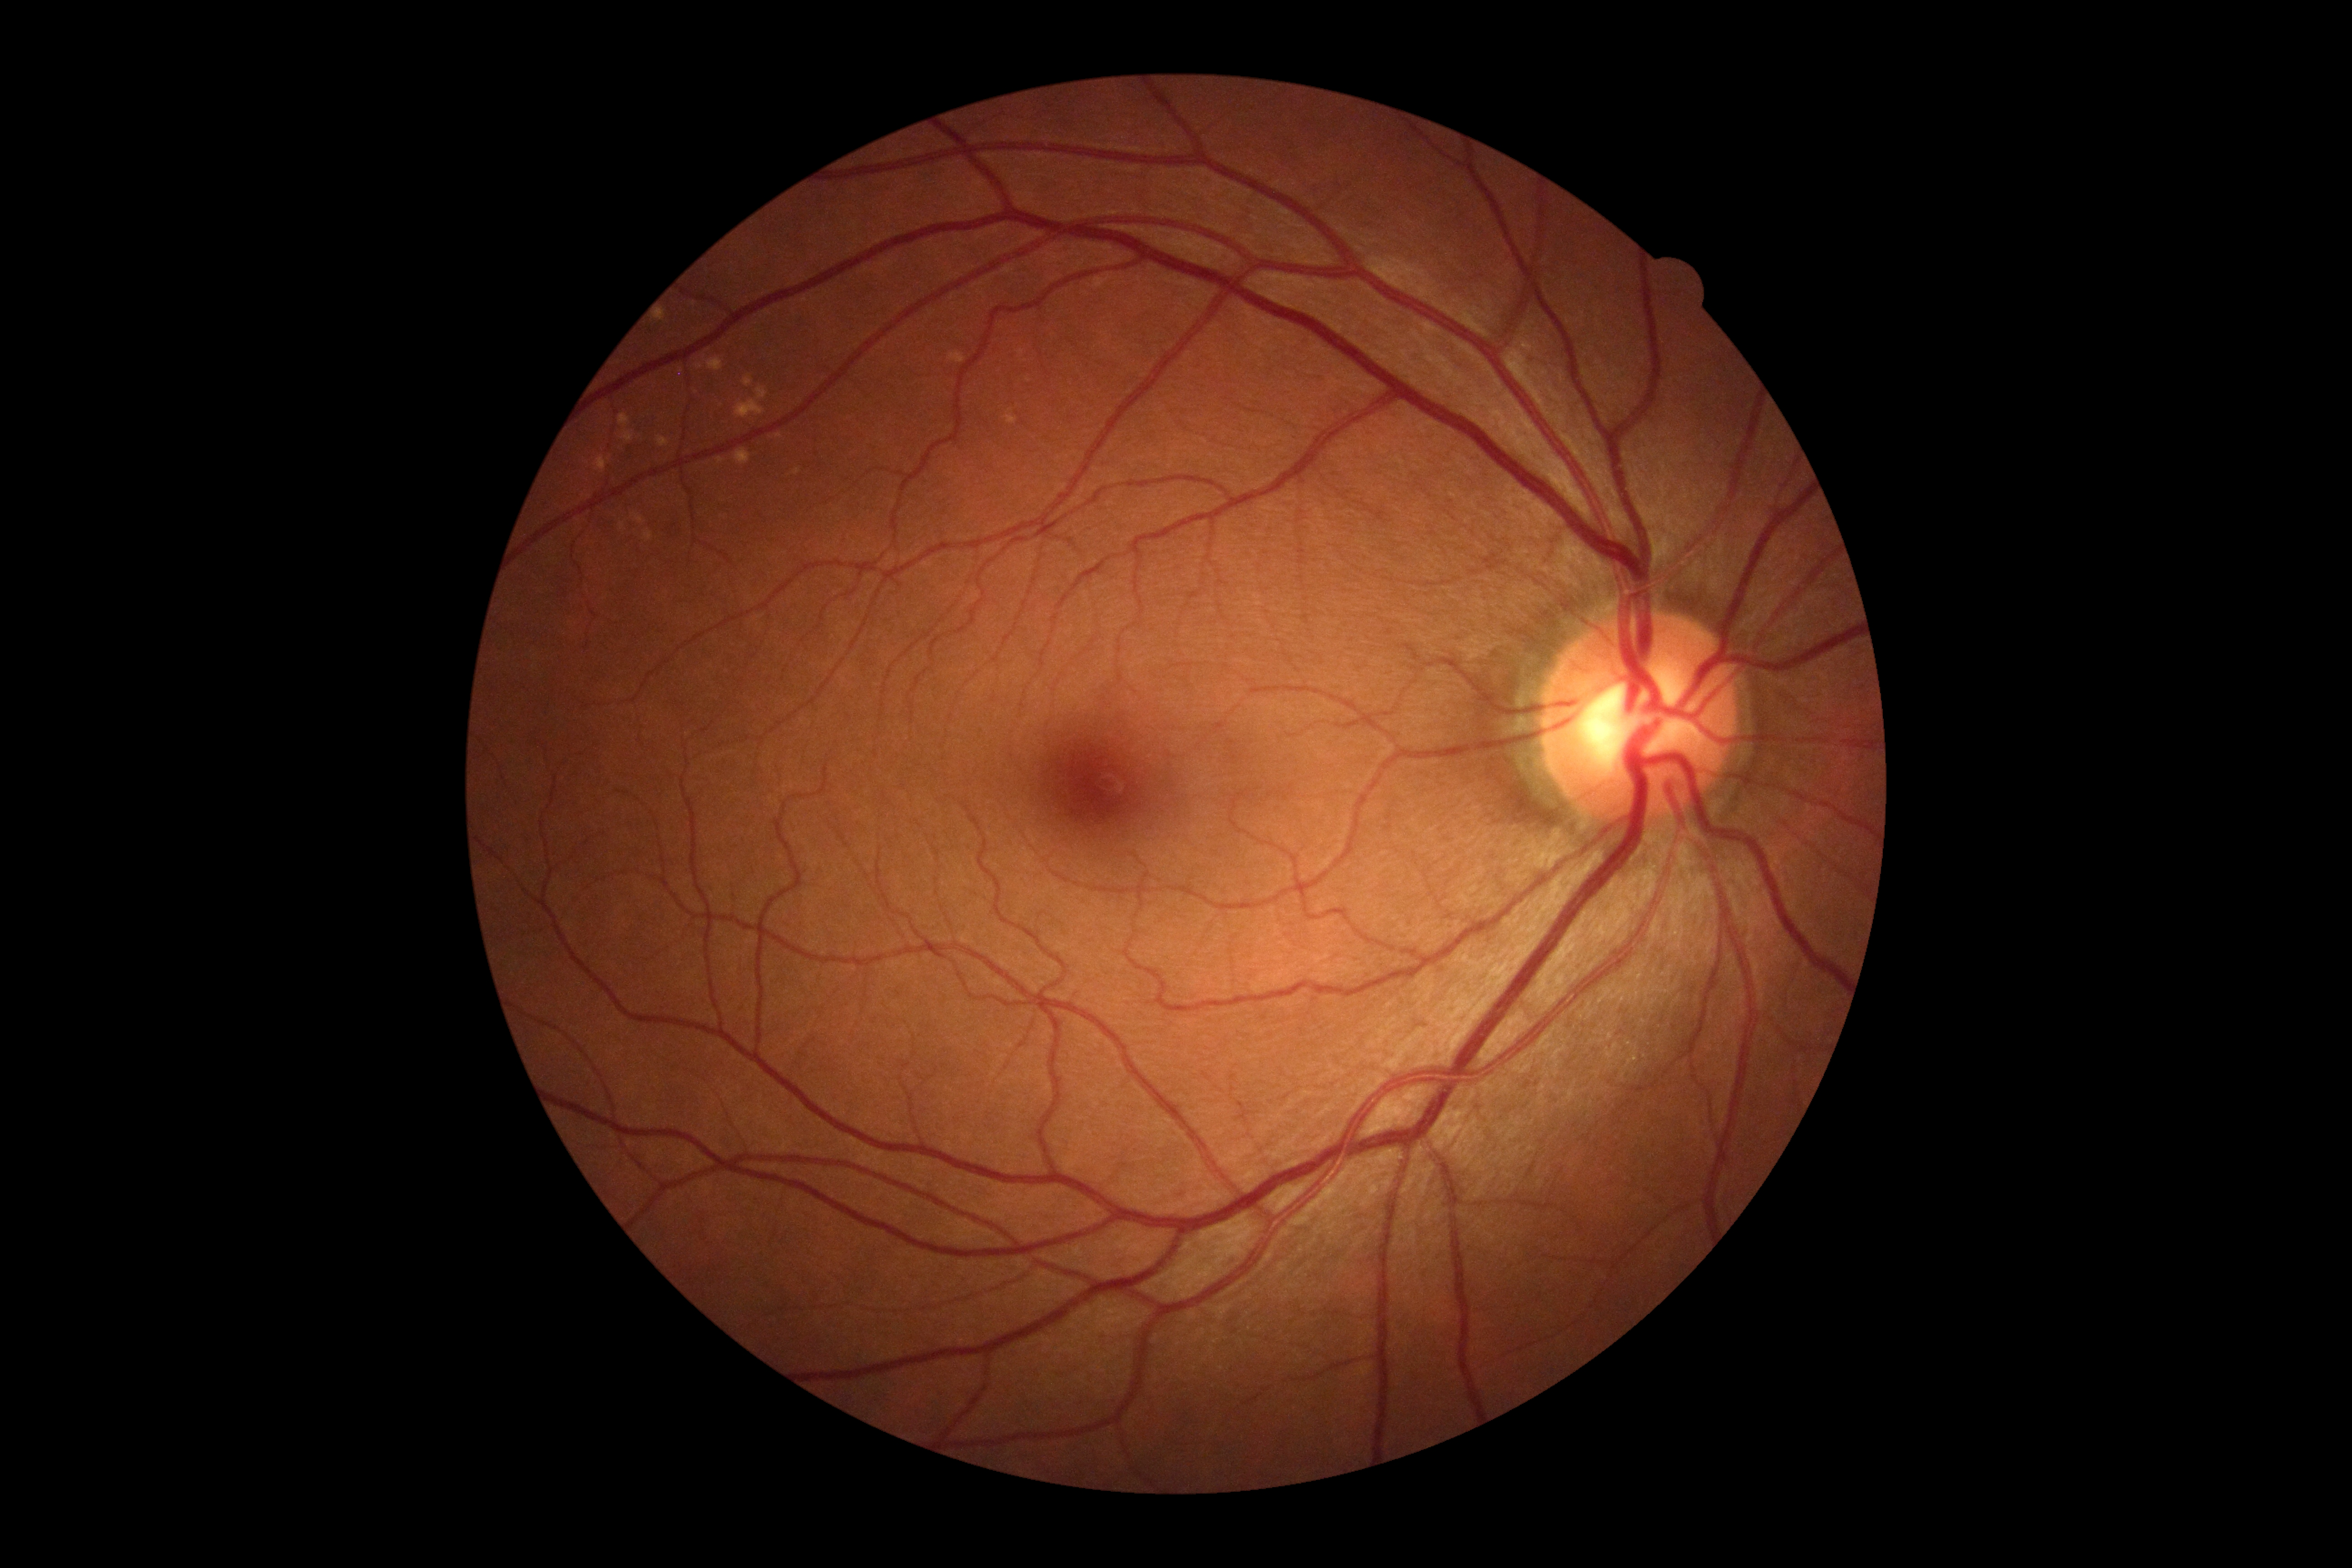

DR impression: no DR findings, diabetic retinopathy (DR): no apparent diabetic retinopathy (grade 0) — no visible signs of diabetic retinopathy.